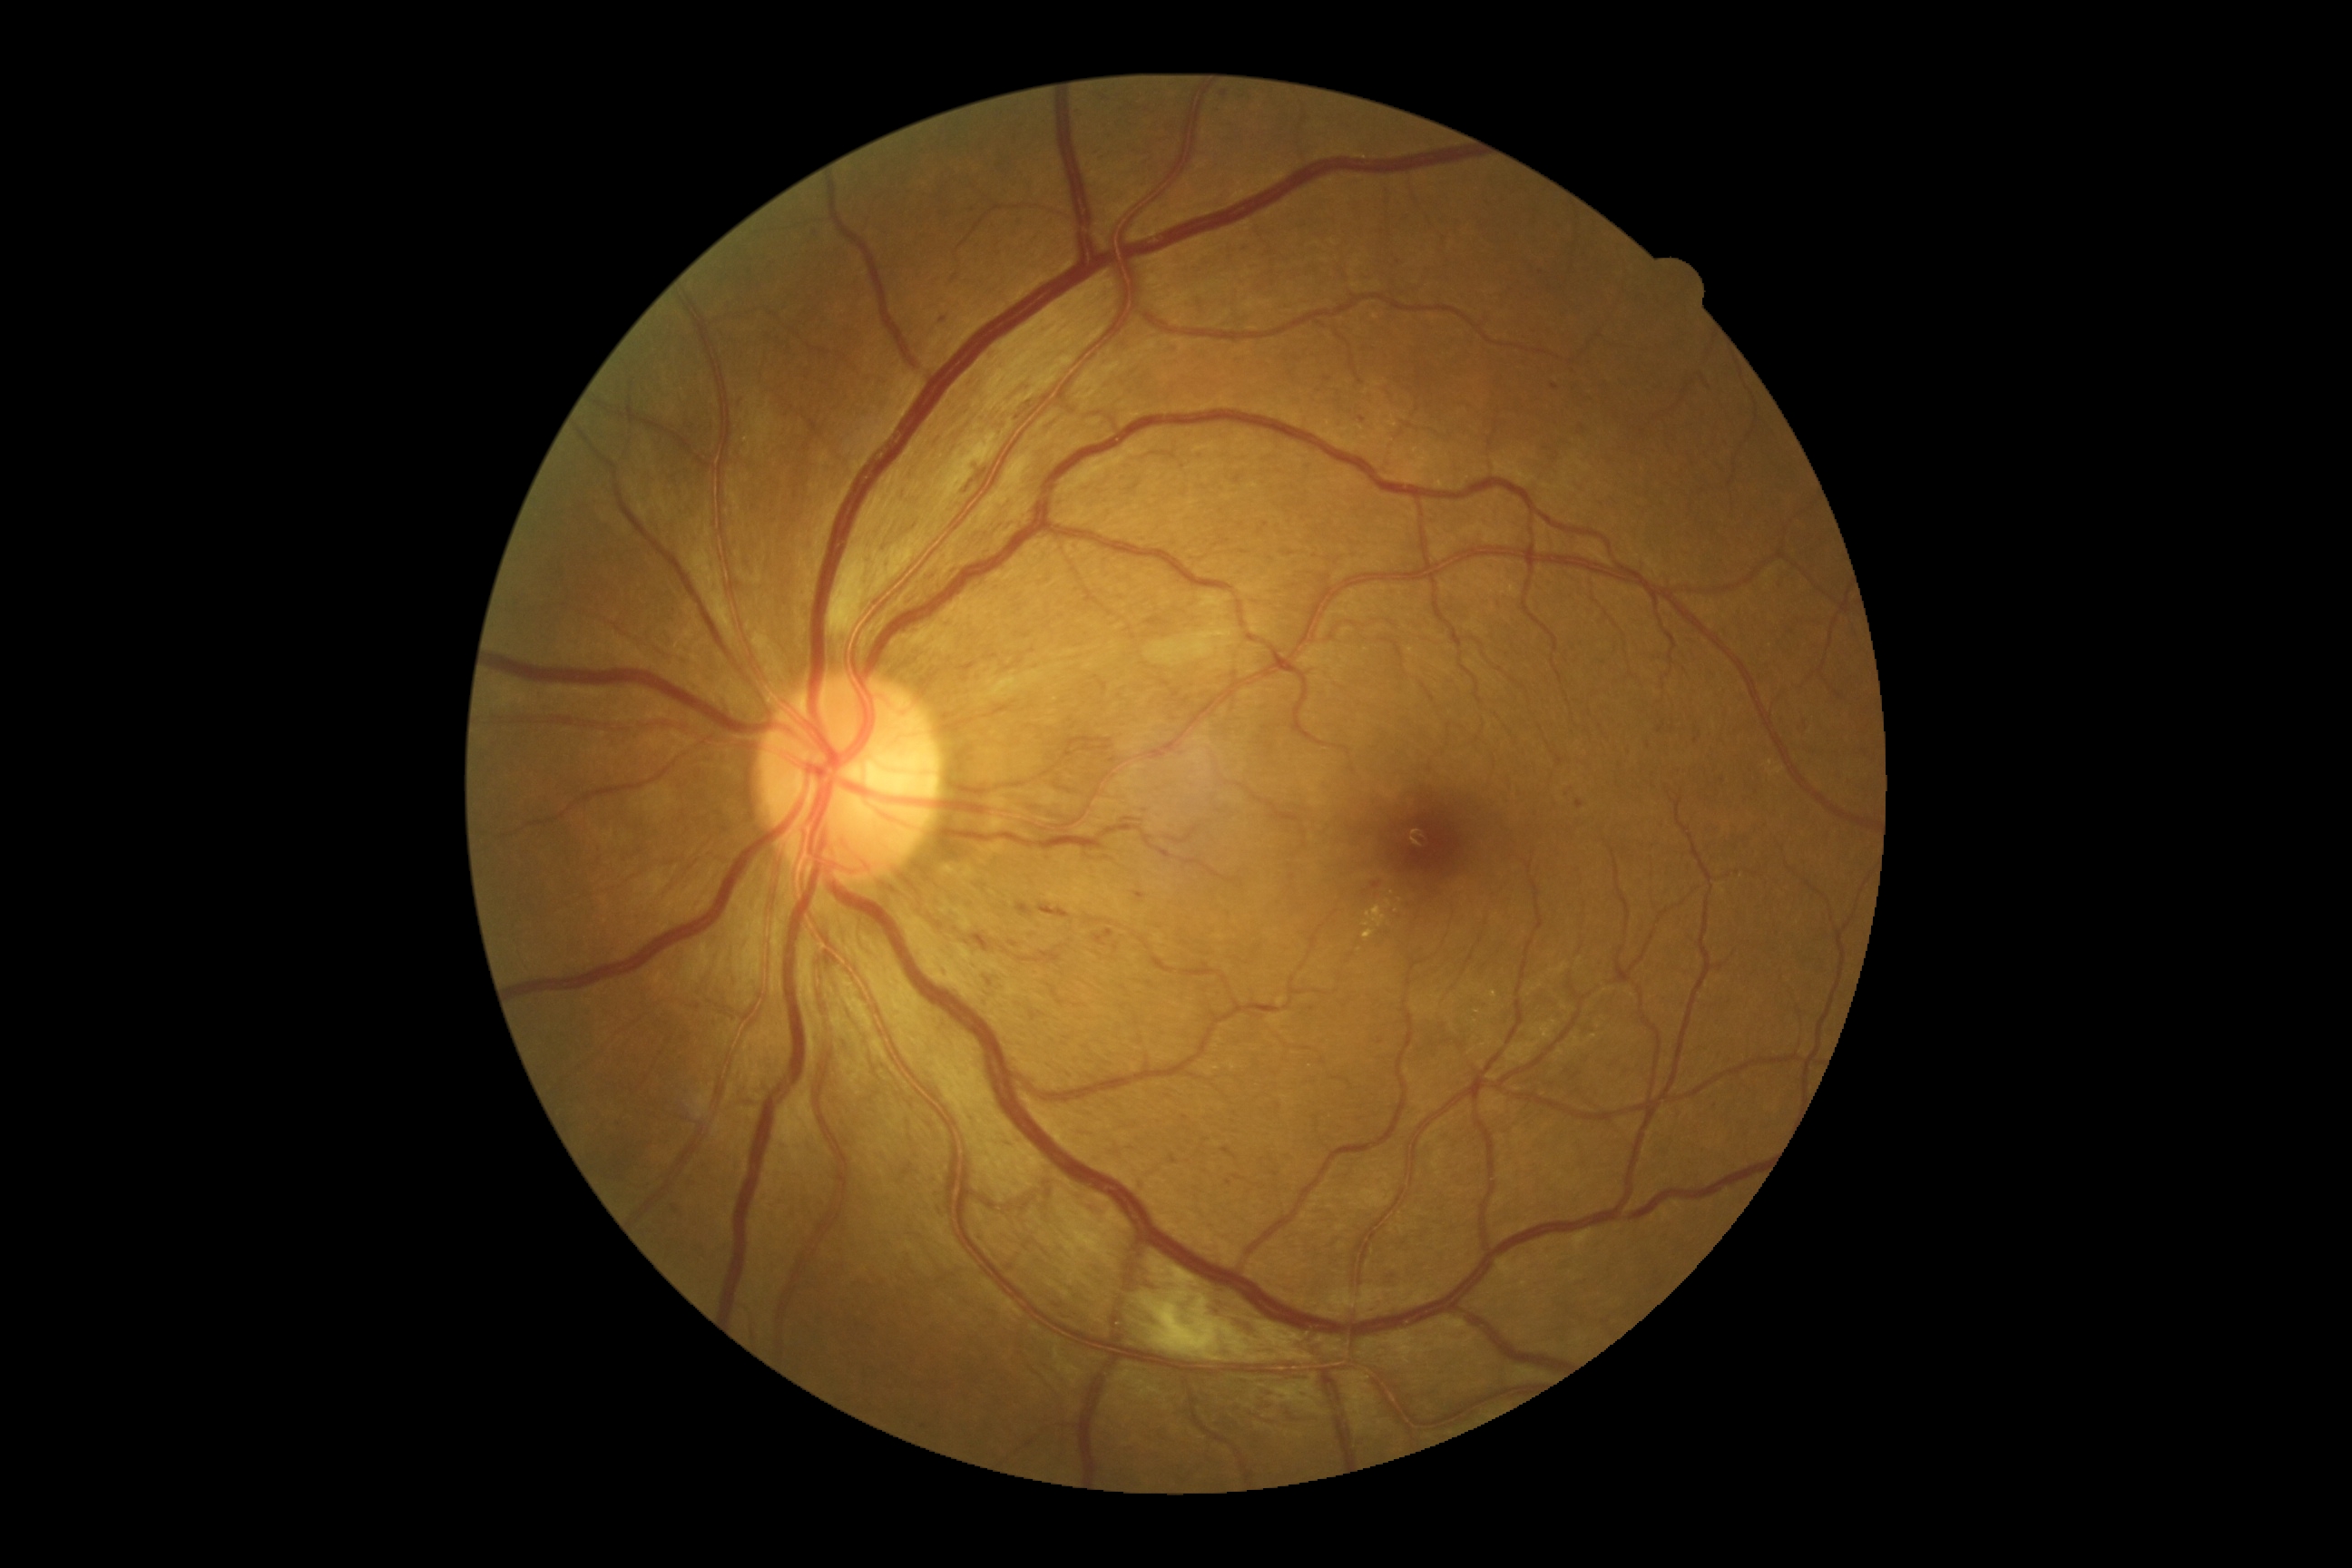

retinopathy grade = moderate NPDR (2)
DR class = non-proliferative diabetic retinopathy